Portable fundus camera image
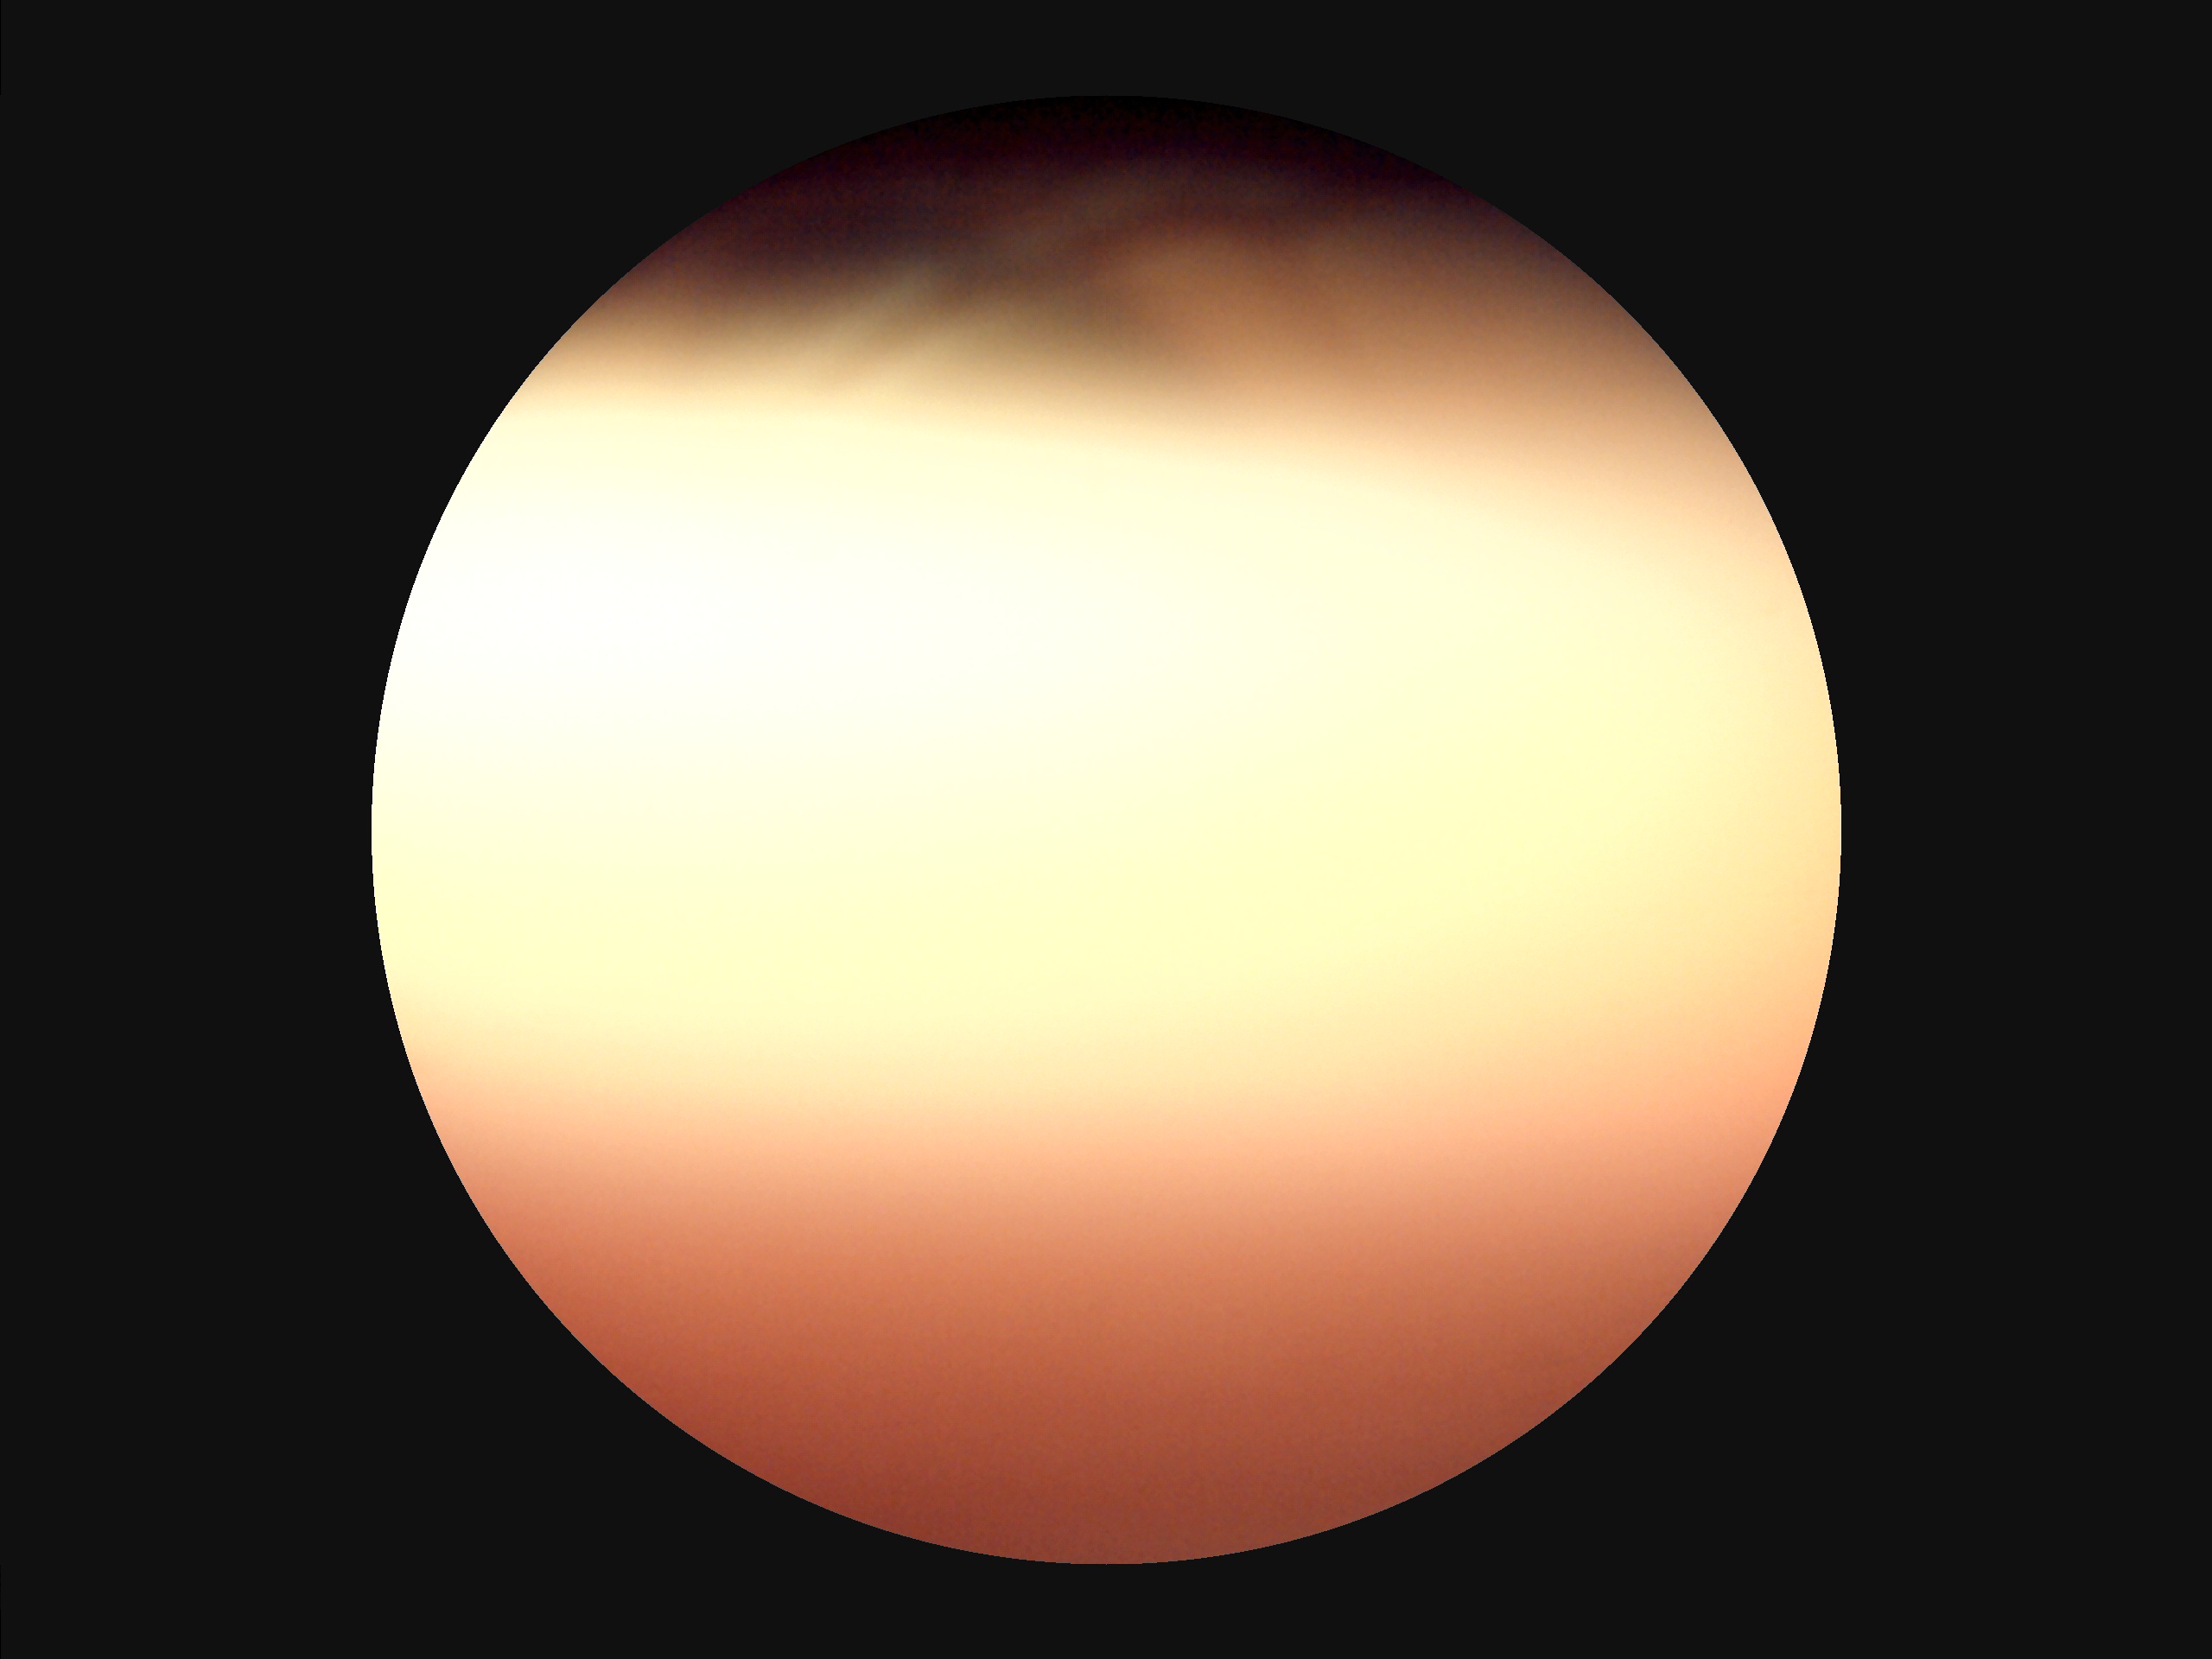

Overall image quality is poor. Illumination is uneven. Noticeable blur in the optic disc, vessels, or background. Narrow intensity range; structures are hard to distinguish.